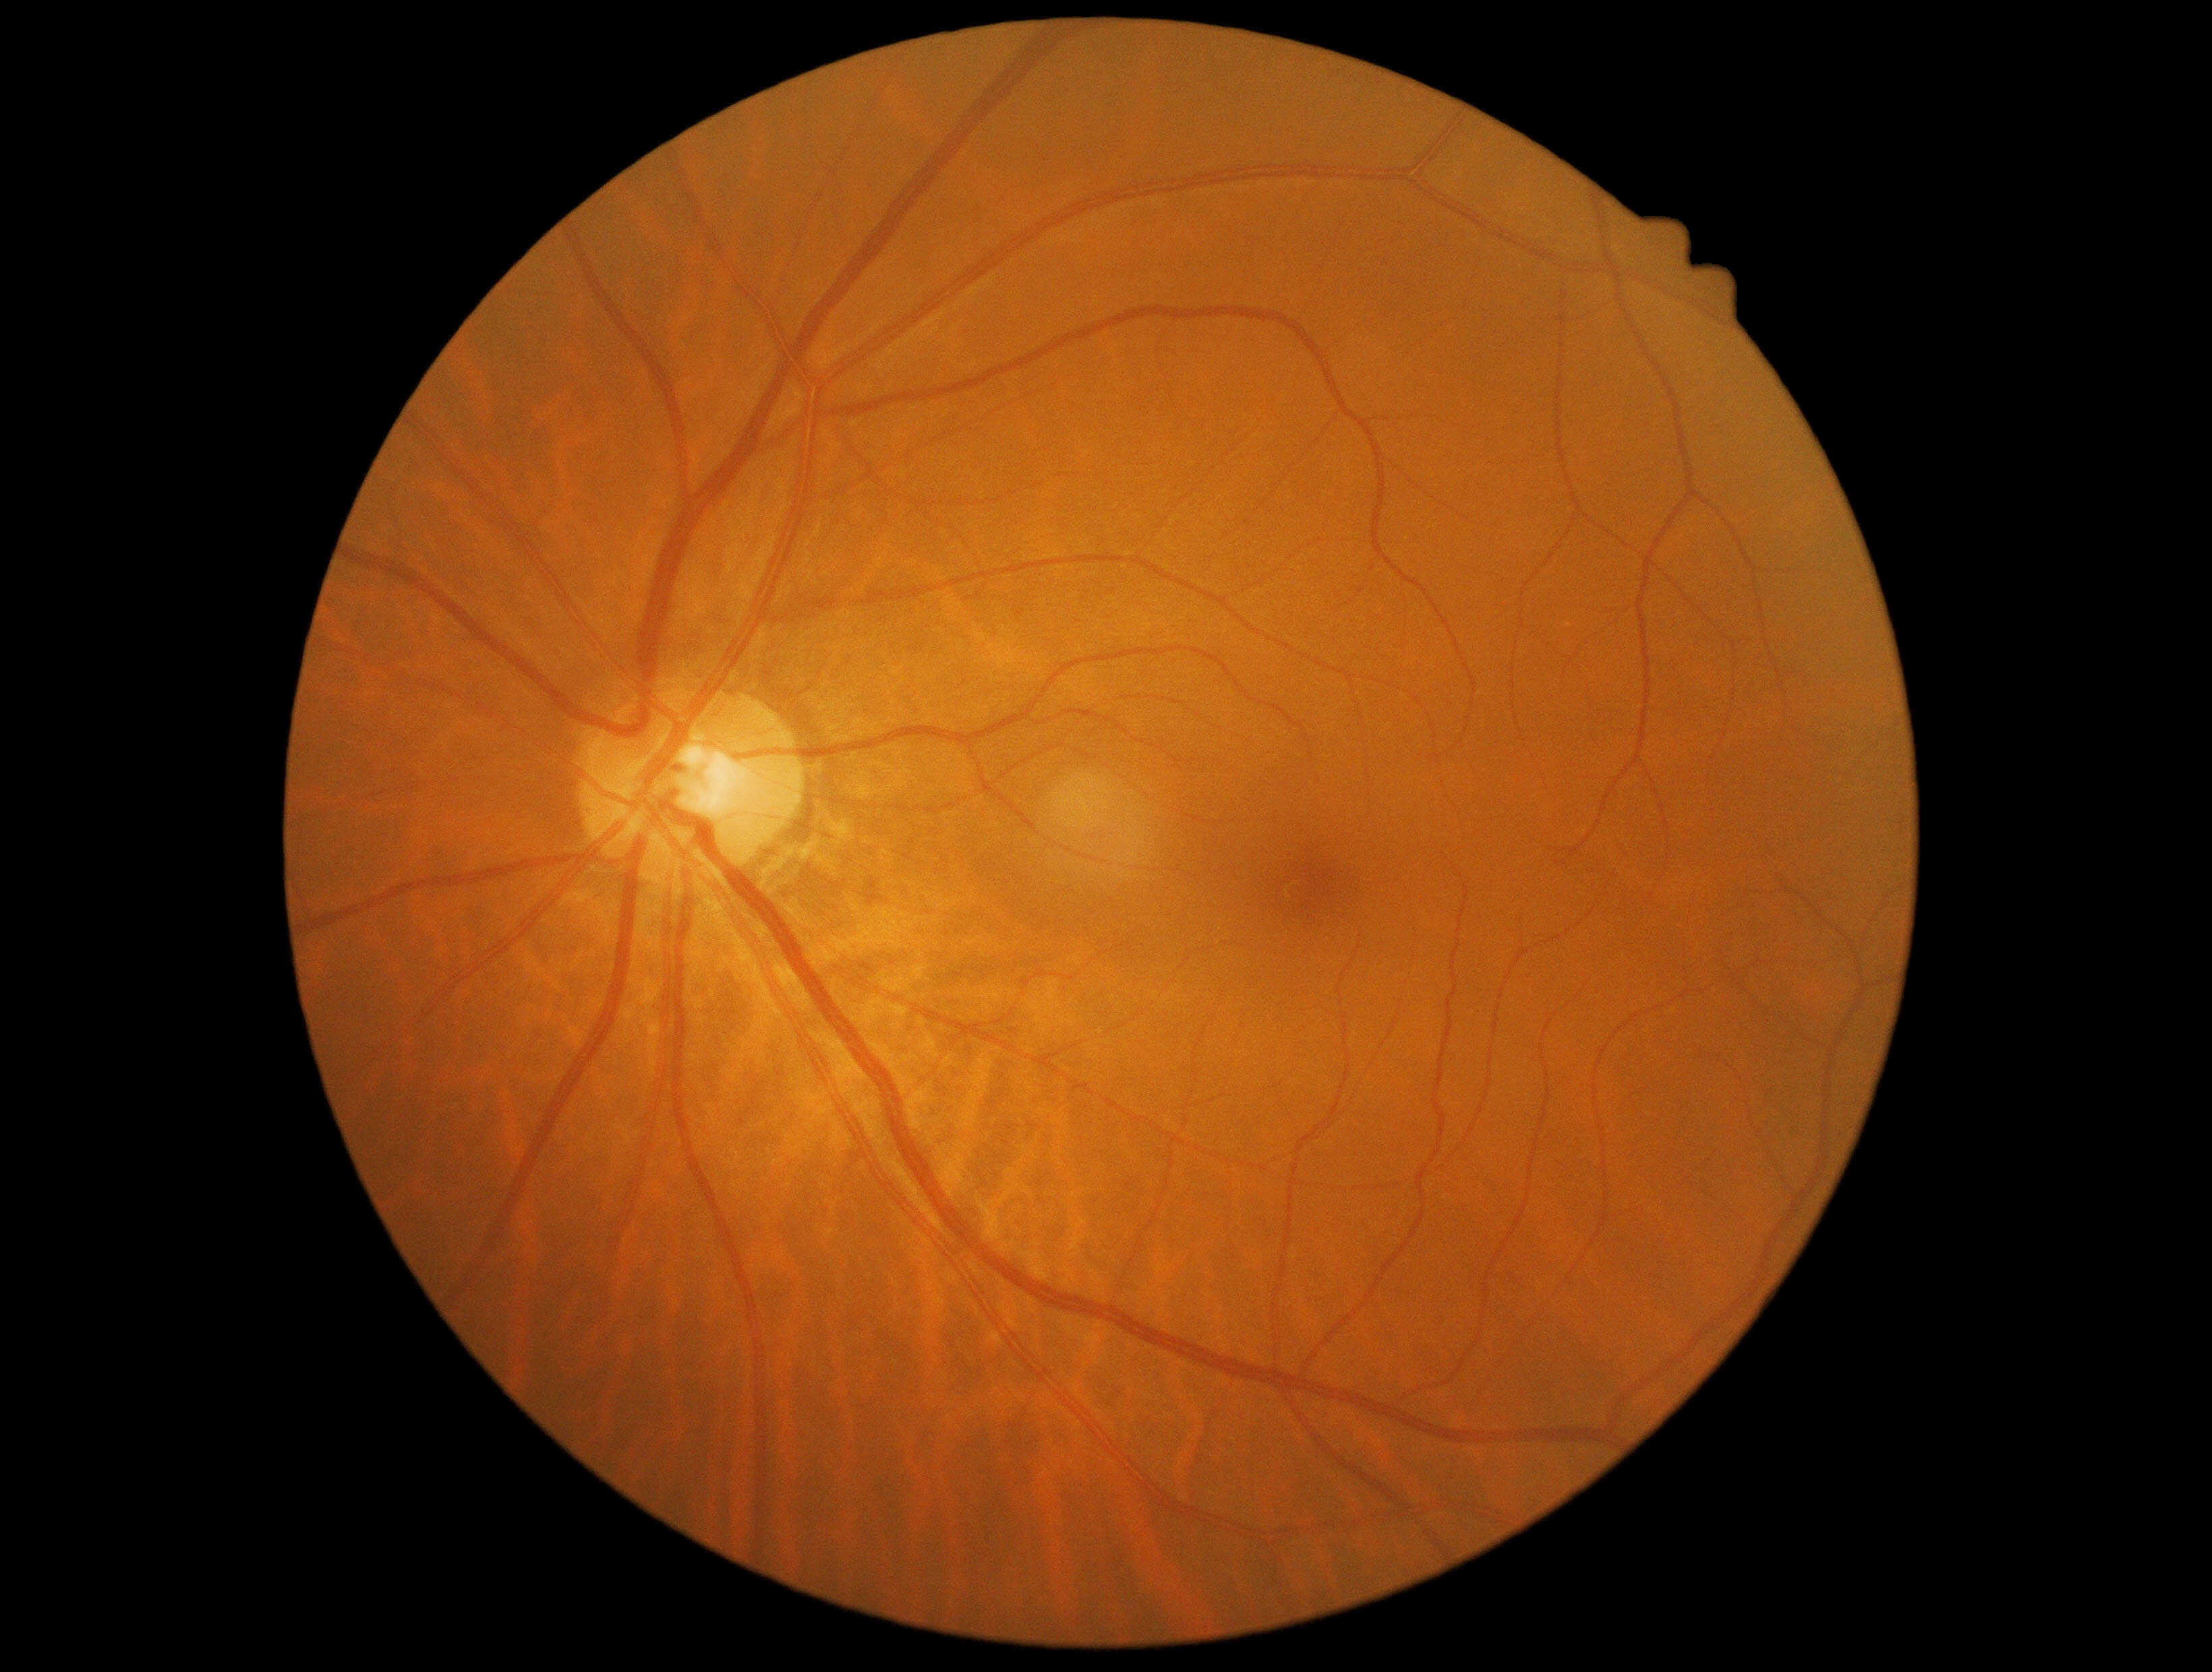 Diabetic retinopathy (DR) is no apparent diabetic retinopathy (grade 0) — no visible signs of diabetic retinopathy.